1536 x 1152 pixels · 45-degree field of view · CFP.
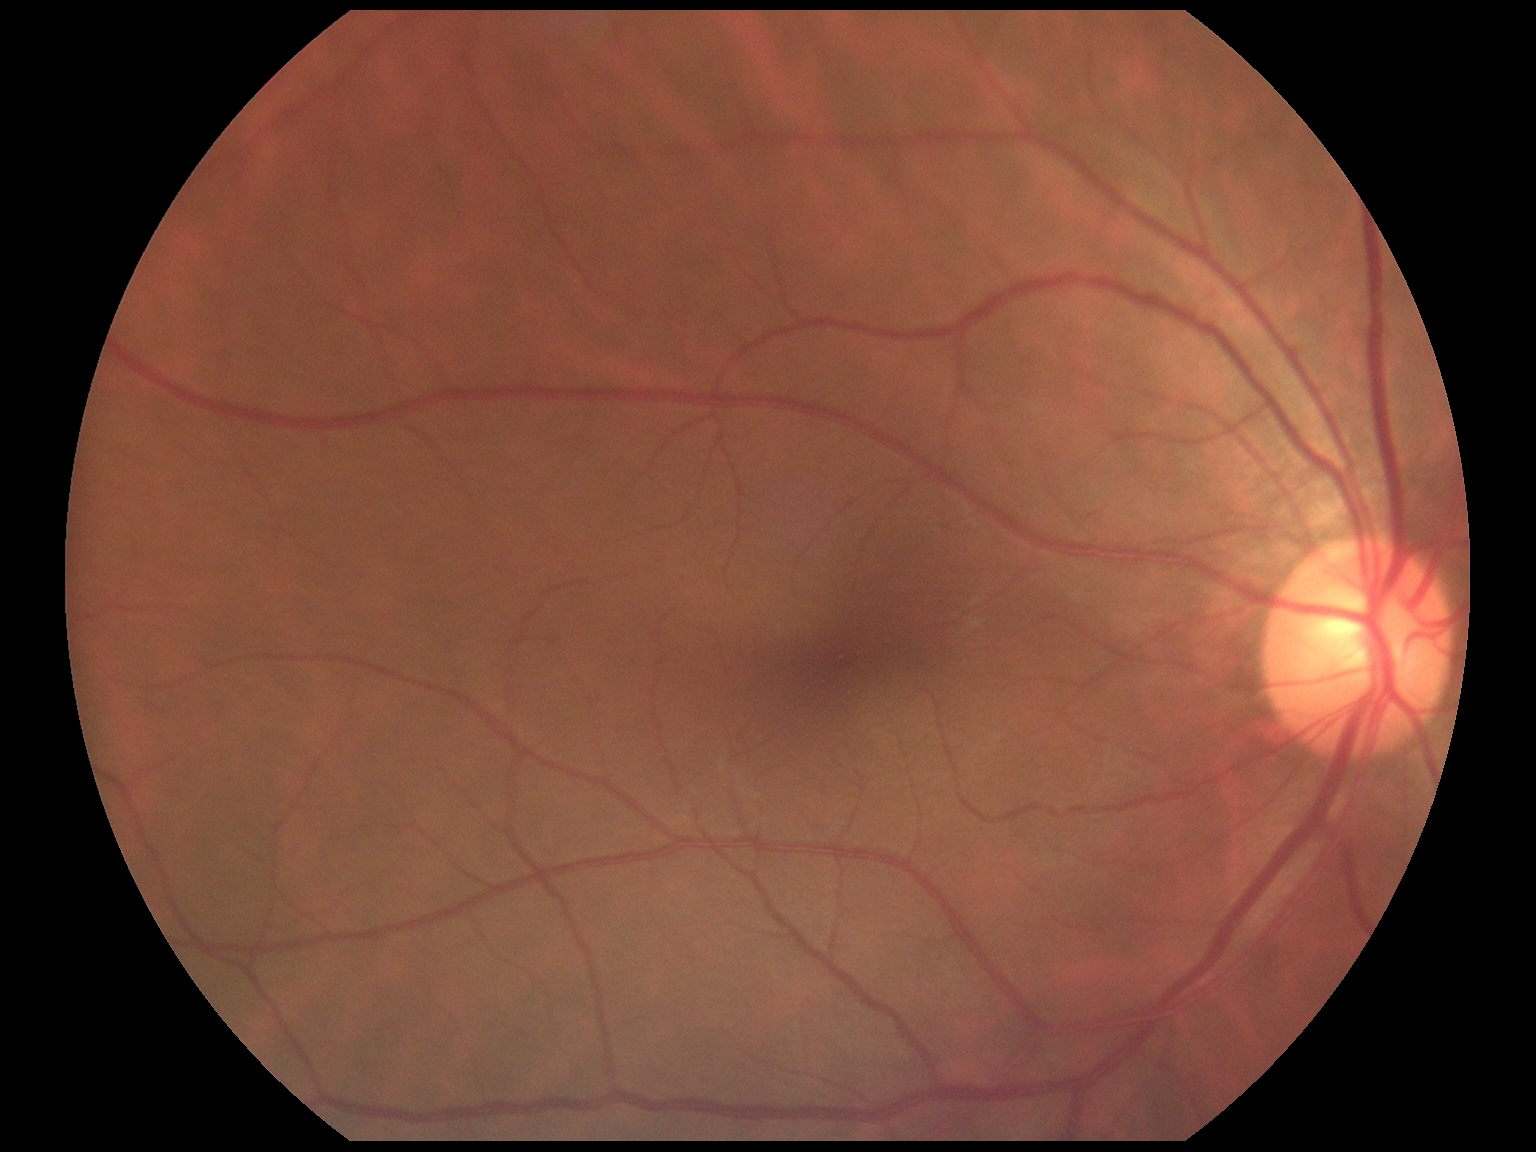 No signs of diabetic retinopathy. DR stage is grade 0.